Davis DR grading. 848 by 848 pixels:
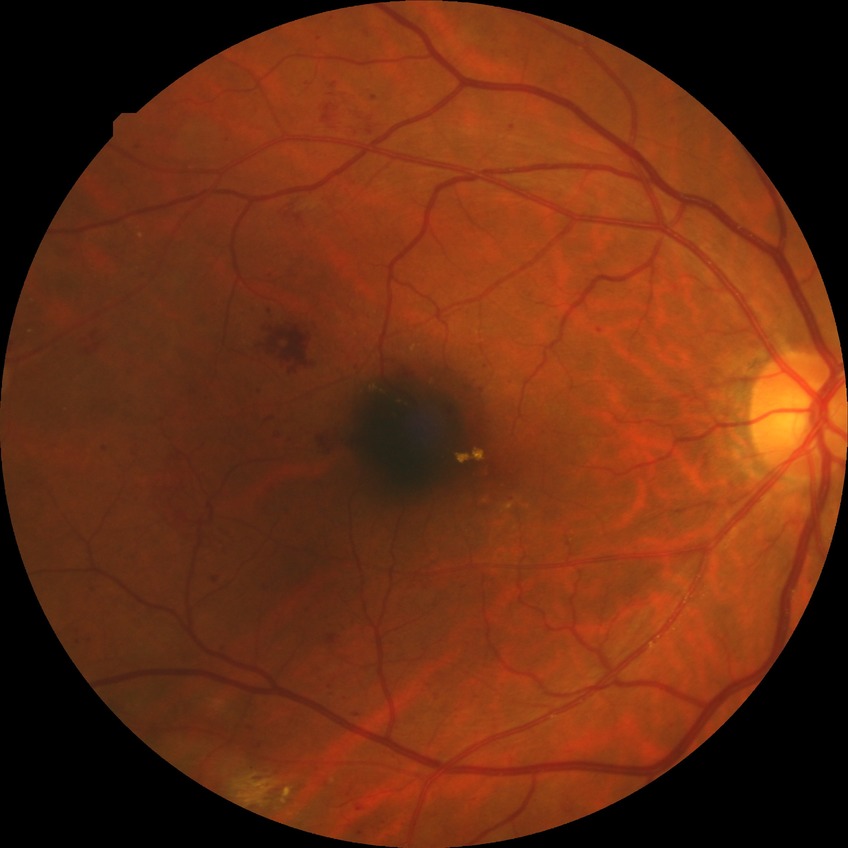
davis_grade: PDR